848x848px. FOV: 45 degrees. Without pupil dilation
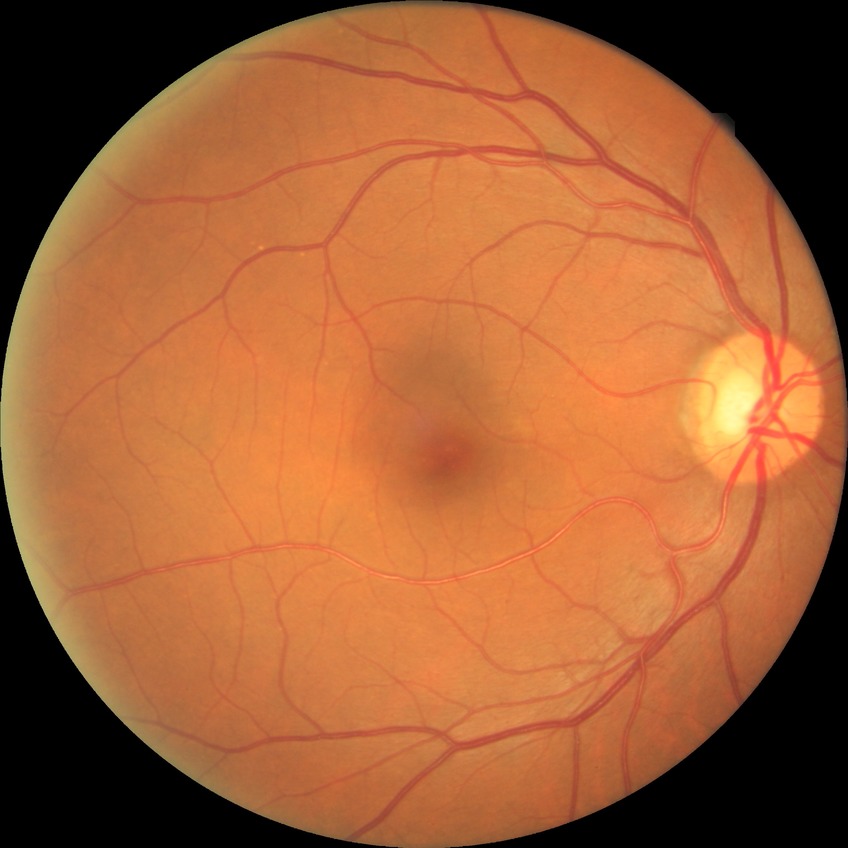 Assessment:
* diabetic retinopathy (DR): no diabetic retinopathy (NDR)